Modified Davis classification; acquired with a NIDEK AFC-230; 848 x 848 pixels; 45 degree fundus photograph:
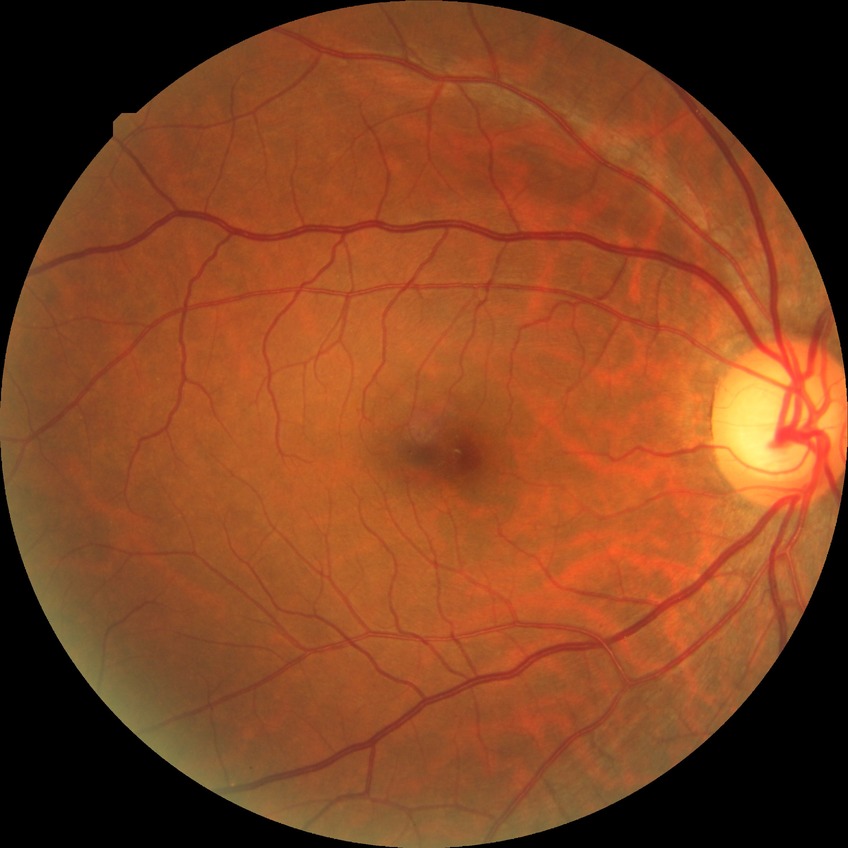
Diabetic retinopathy (DR): simple diabetic retinopathy (SDR).